Davis DR grading, acquired with a NIDEK AFC-230: 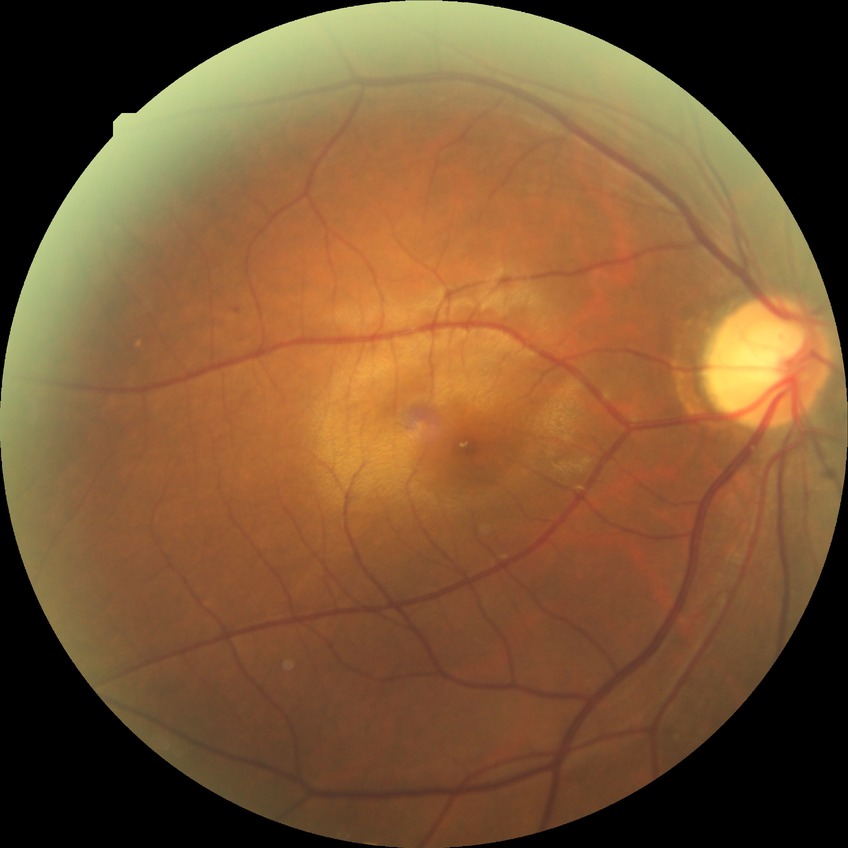

Diabetic retinopathy severity is simple diabetic retinopathy.